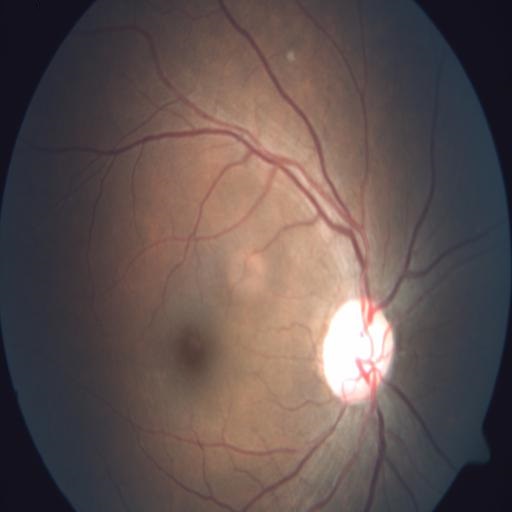

The image shows optic disc pallor.